Pediatric wide-field fundus photograph
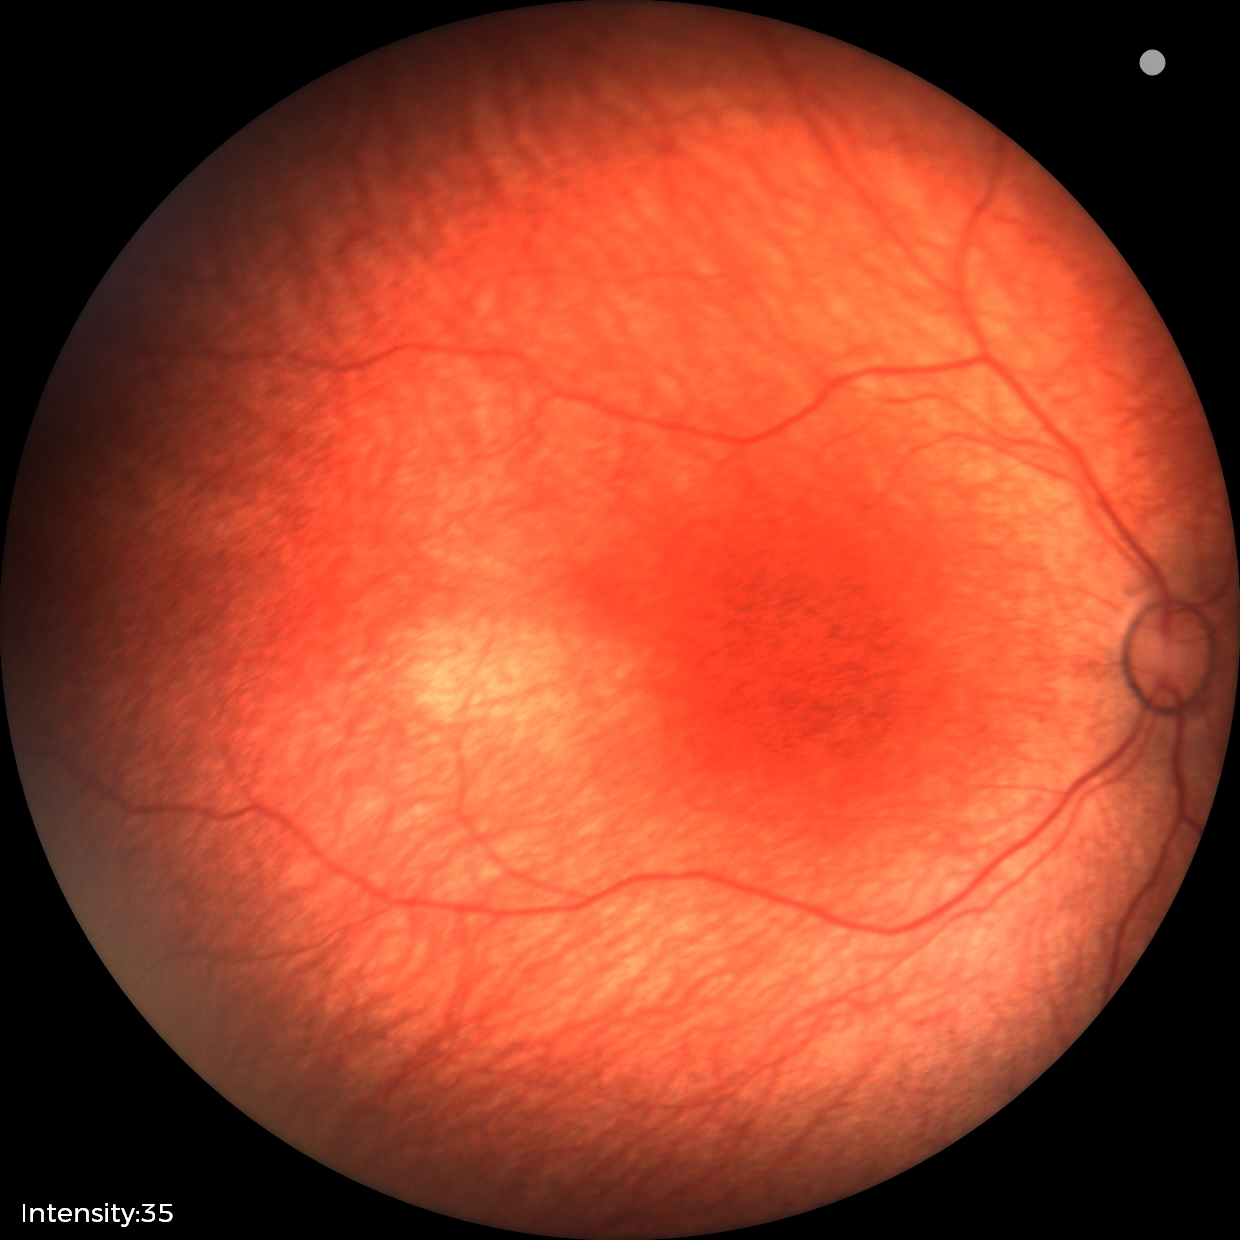 Normal screening examination.